Color fundus image:
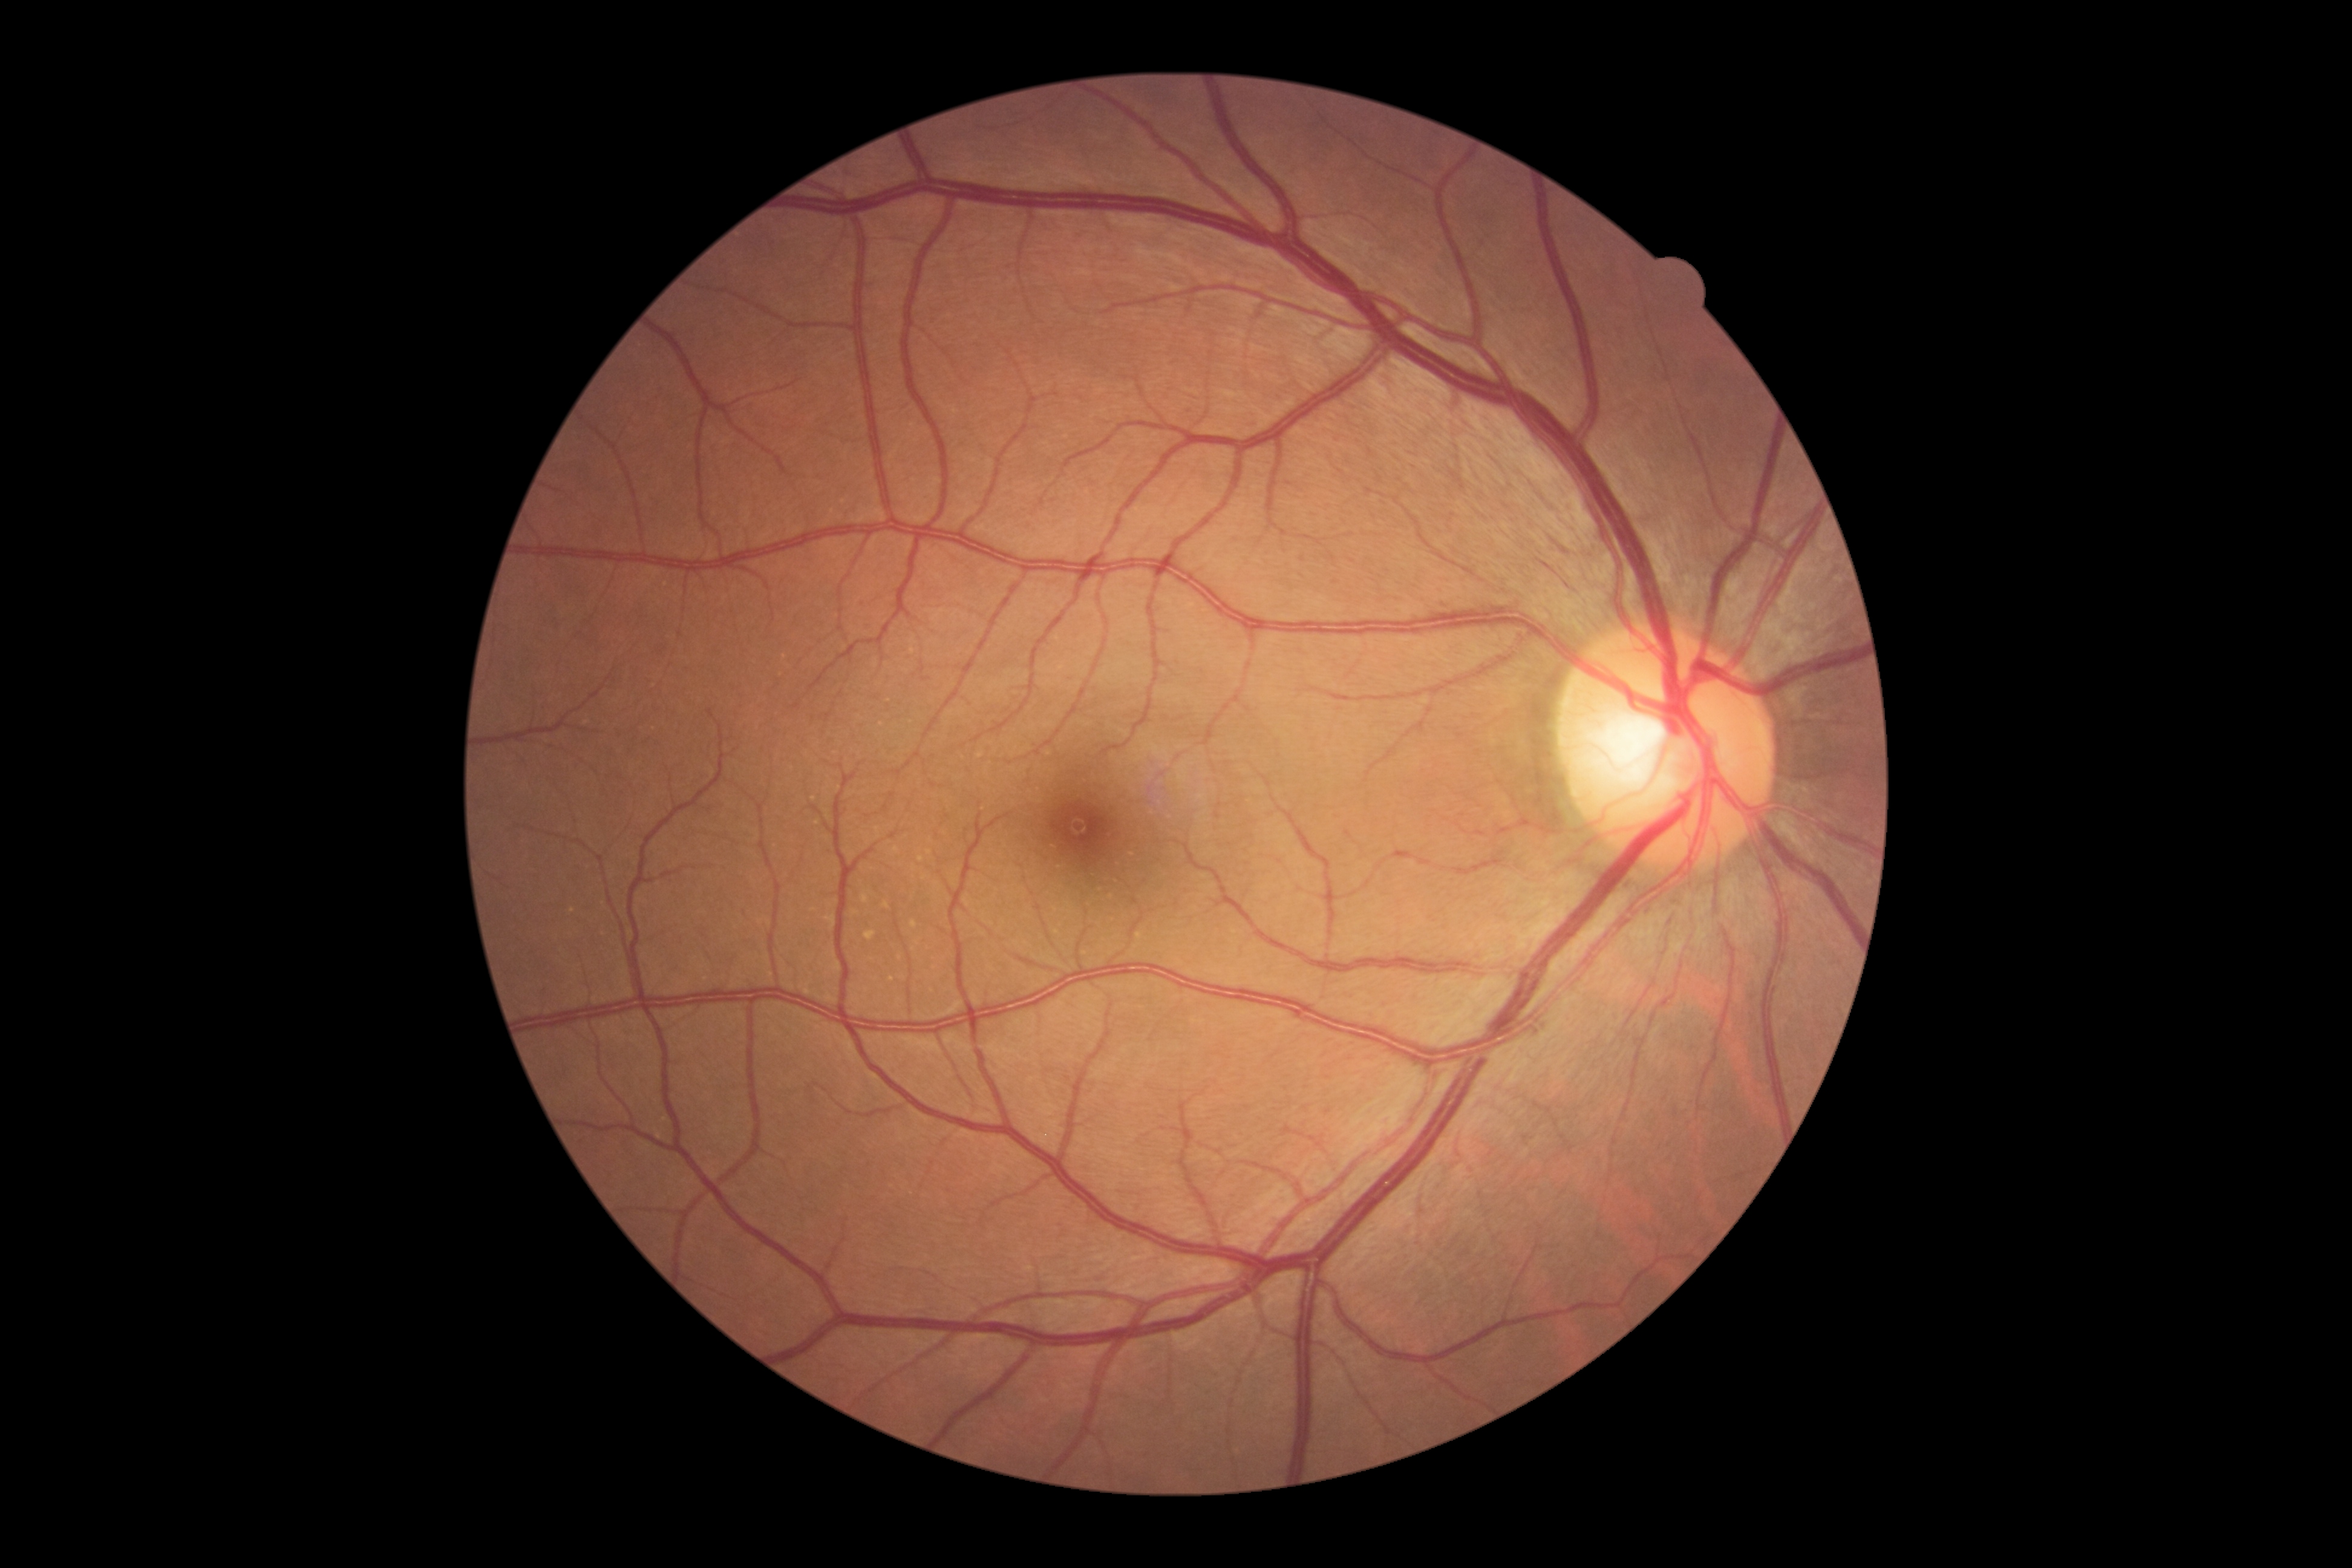 Retinopathy grade is 0.